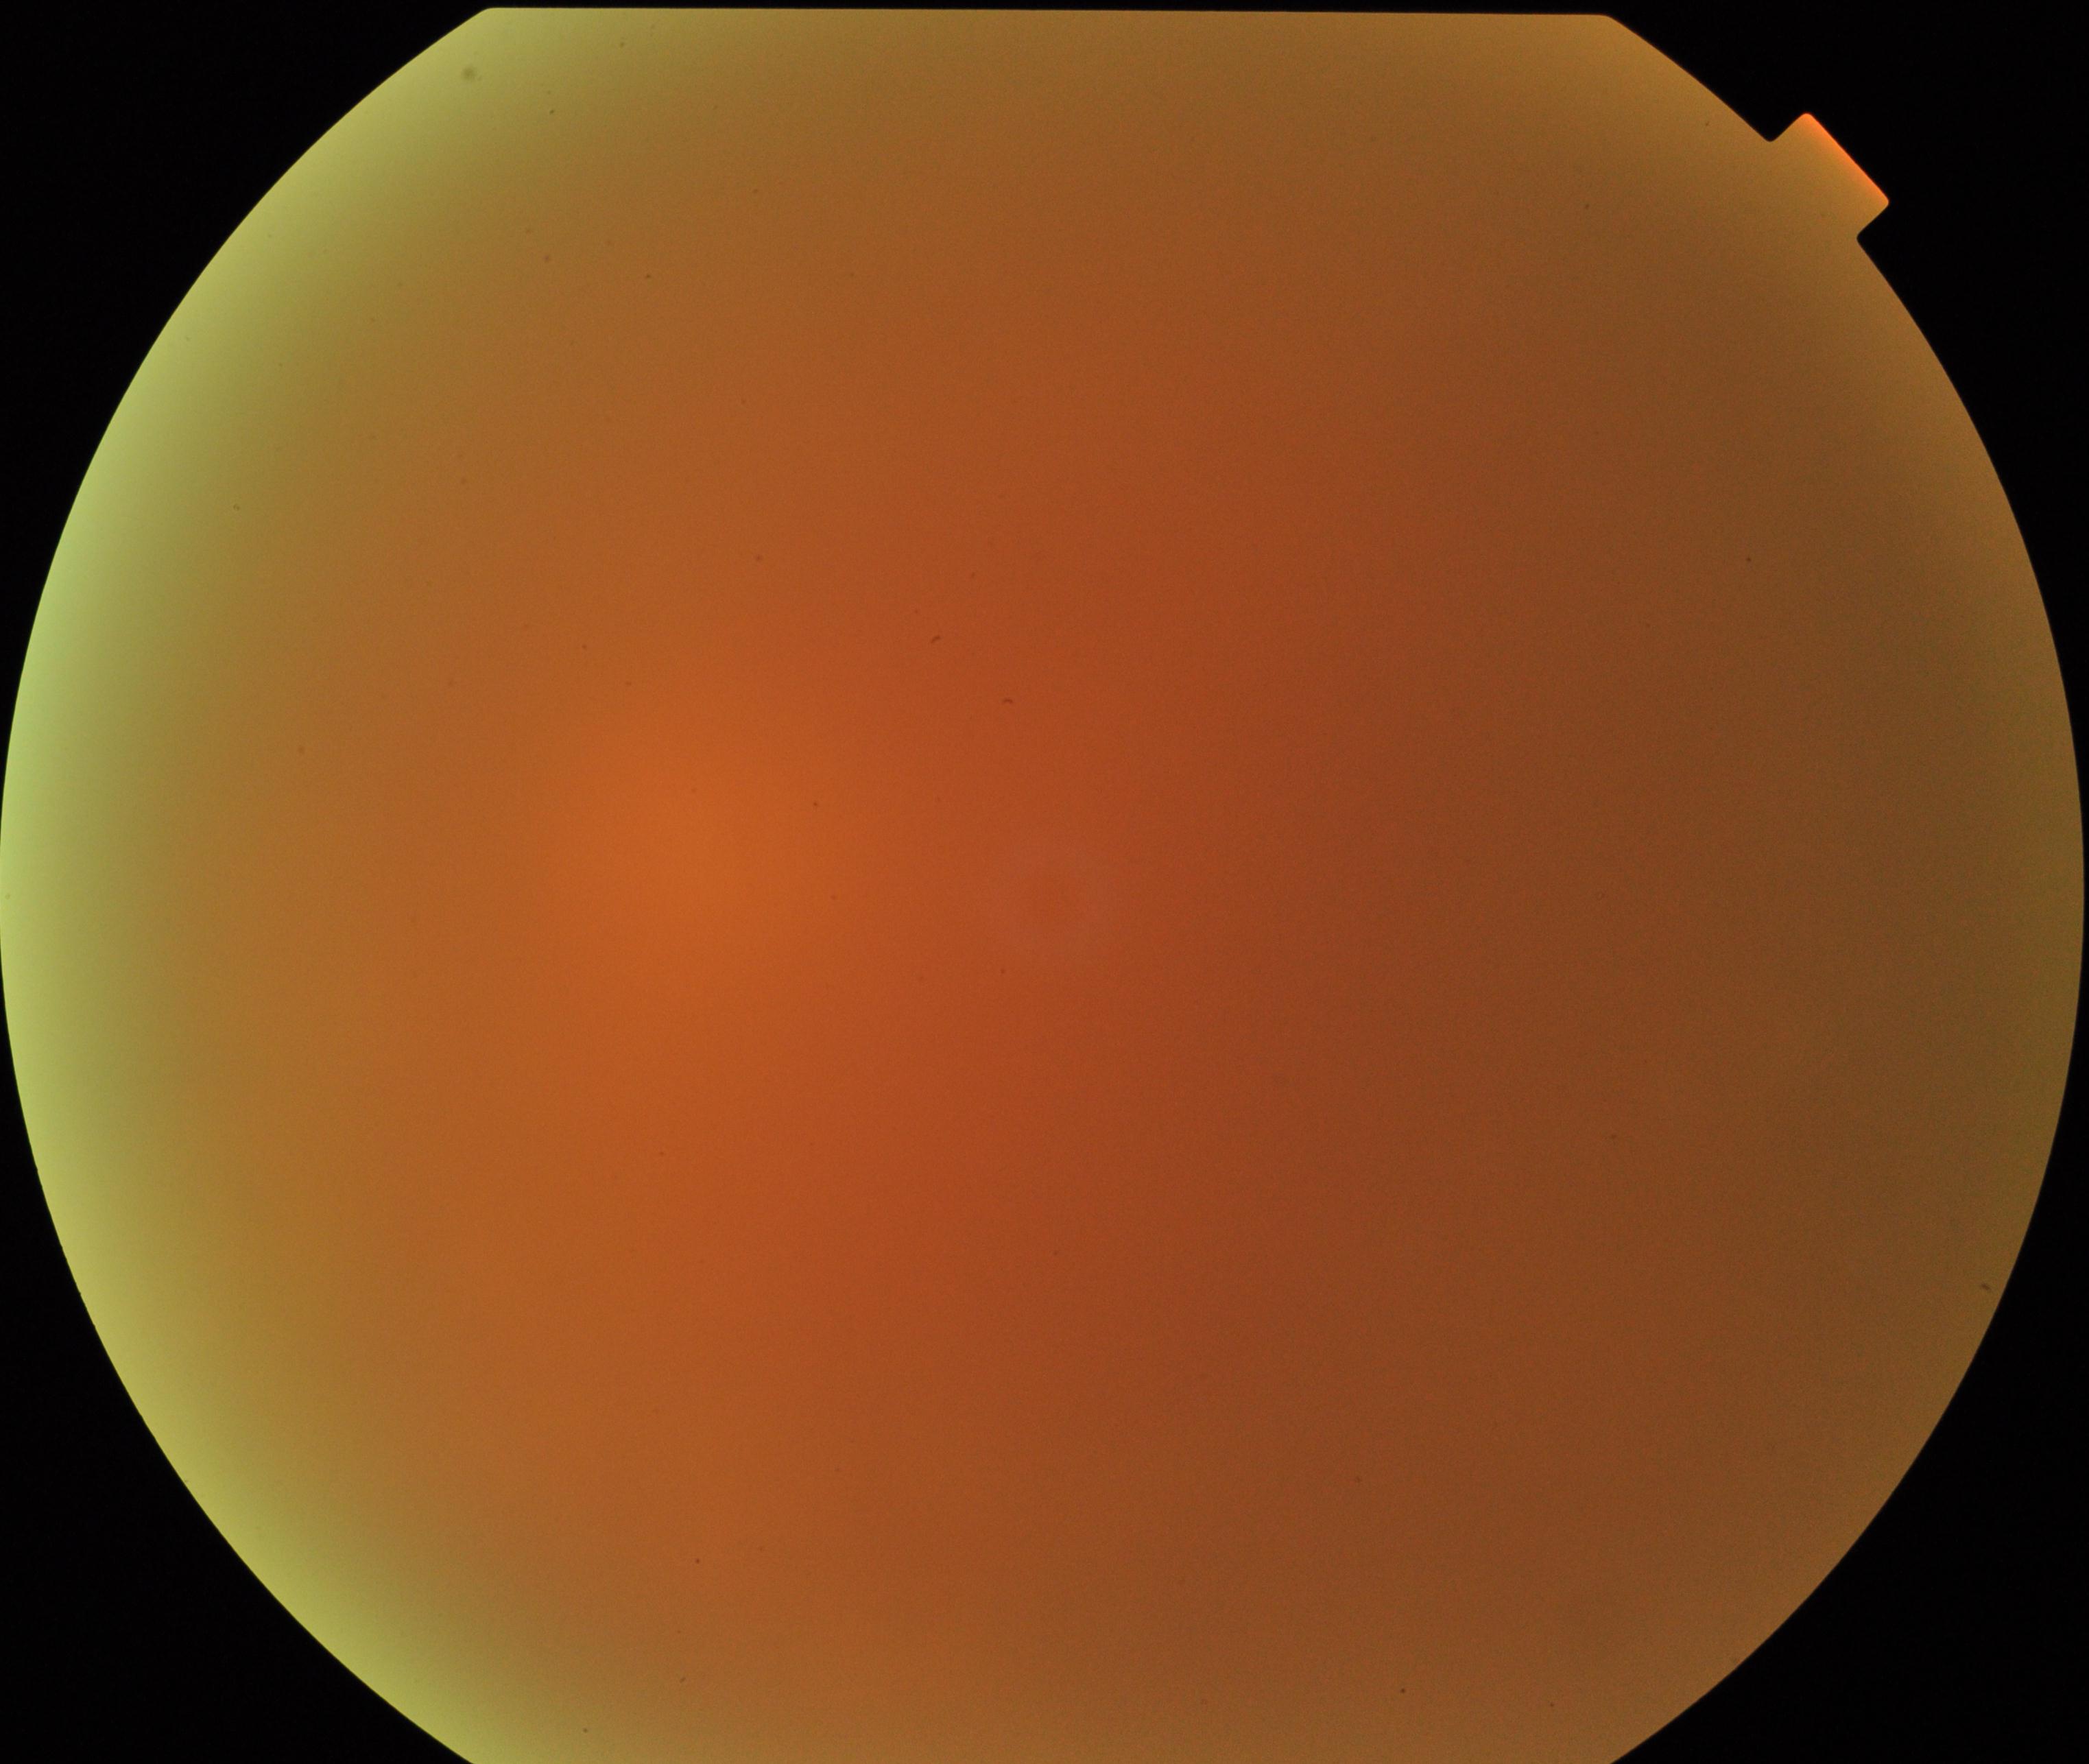 Gradability: poor. Proliferative diabetic retinopathy: no evidence.